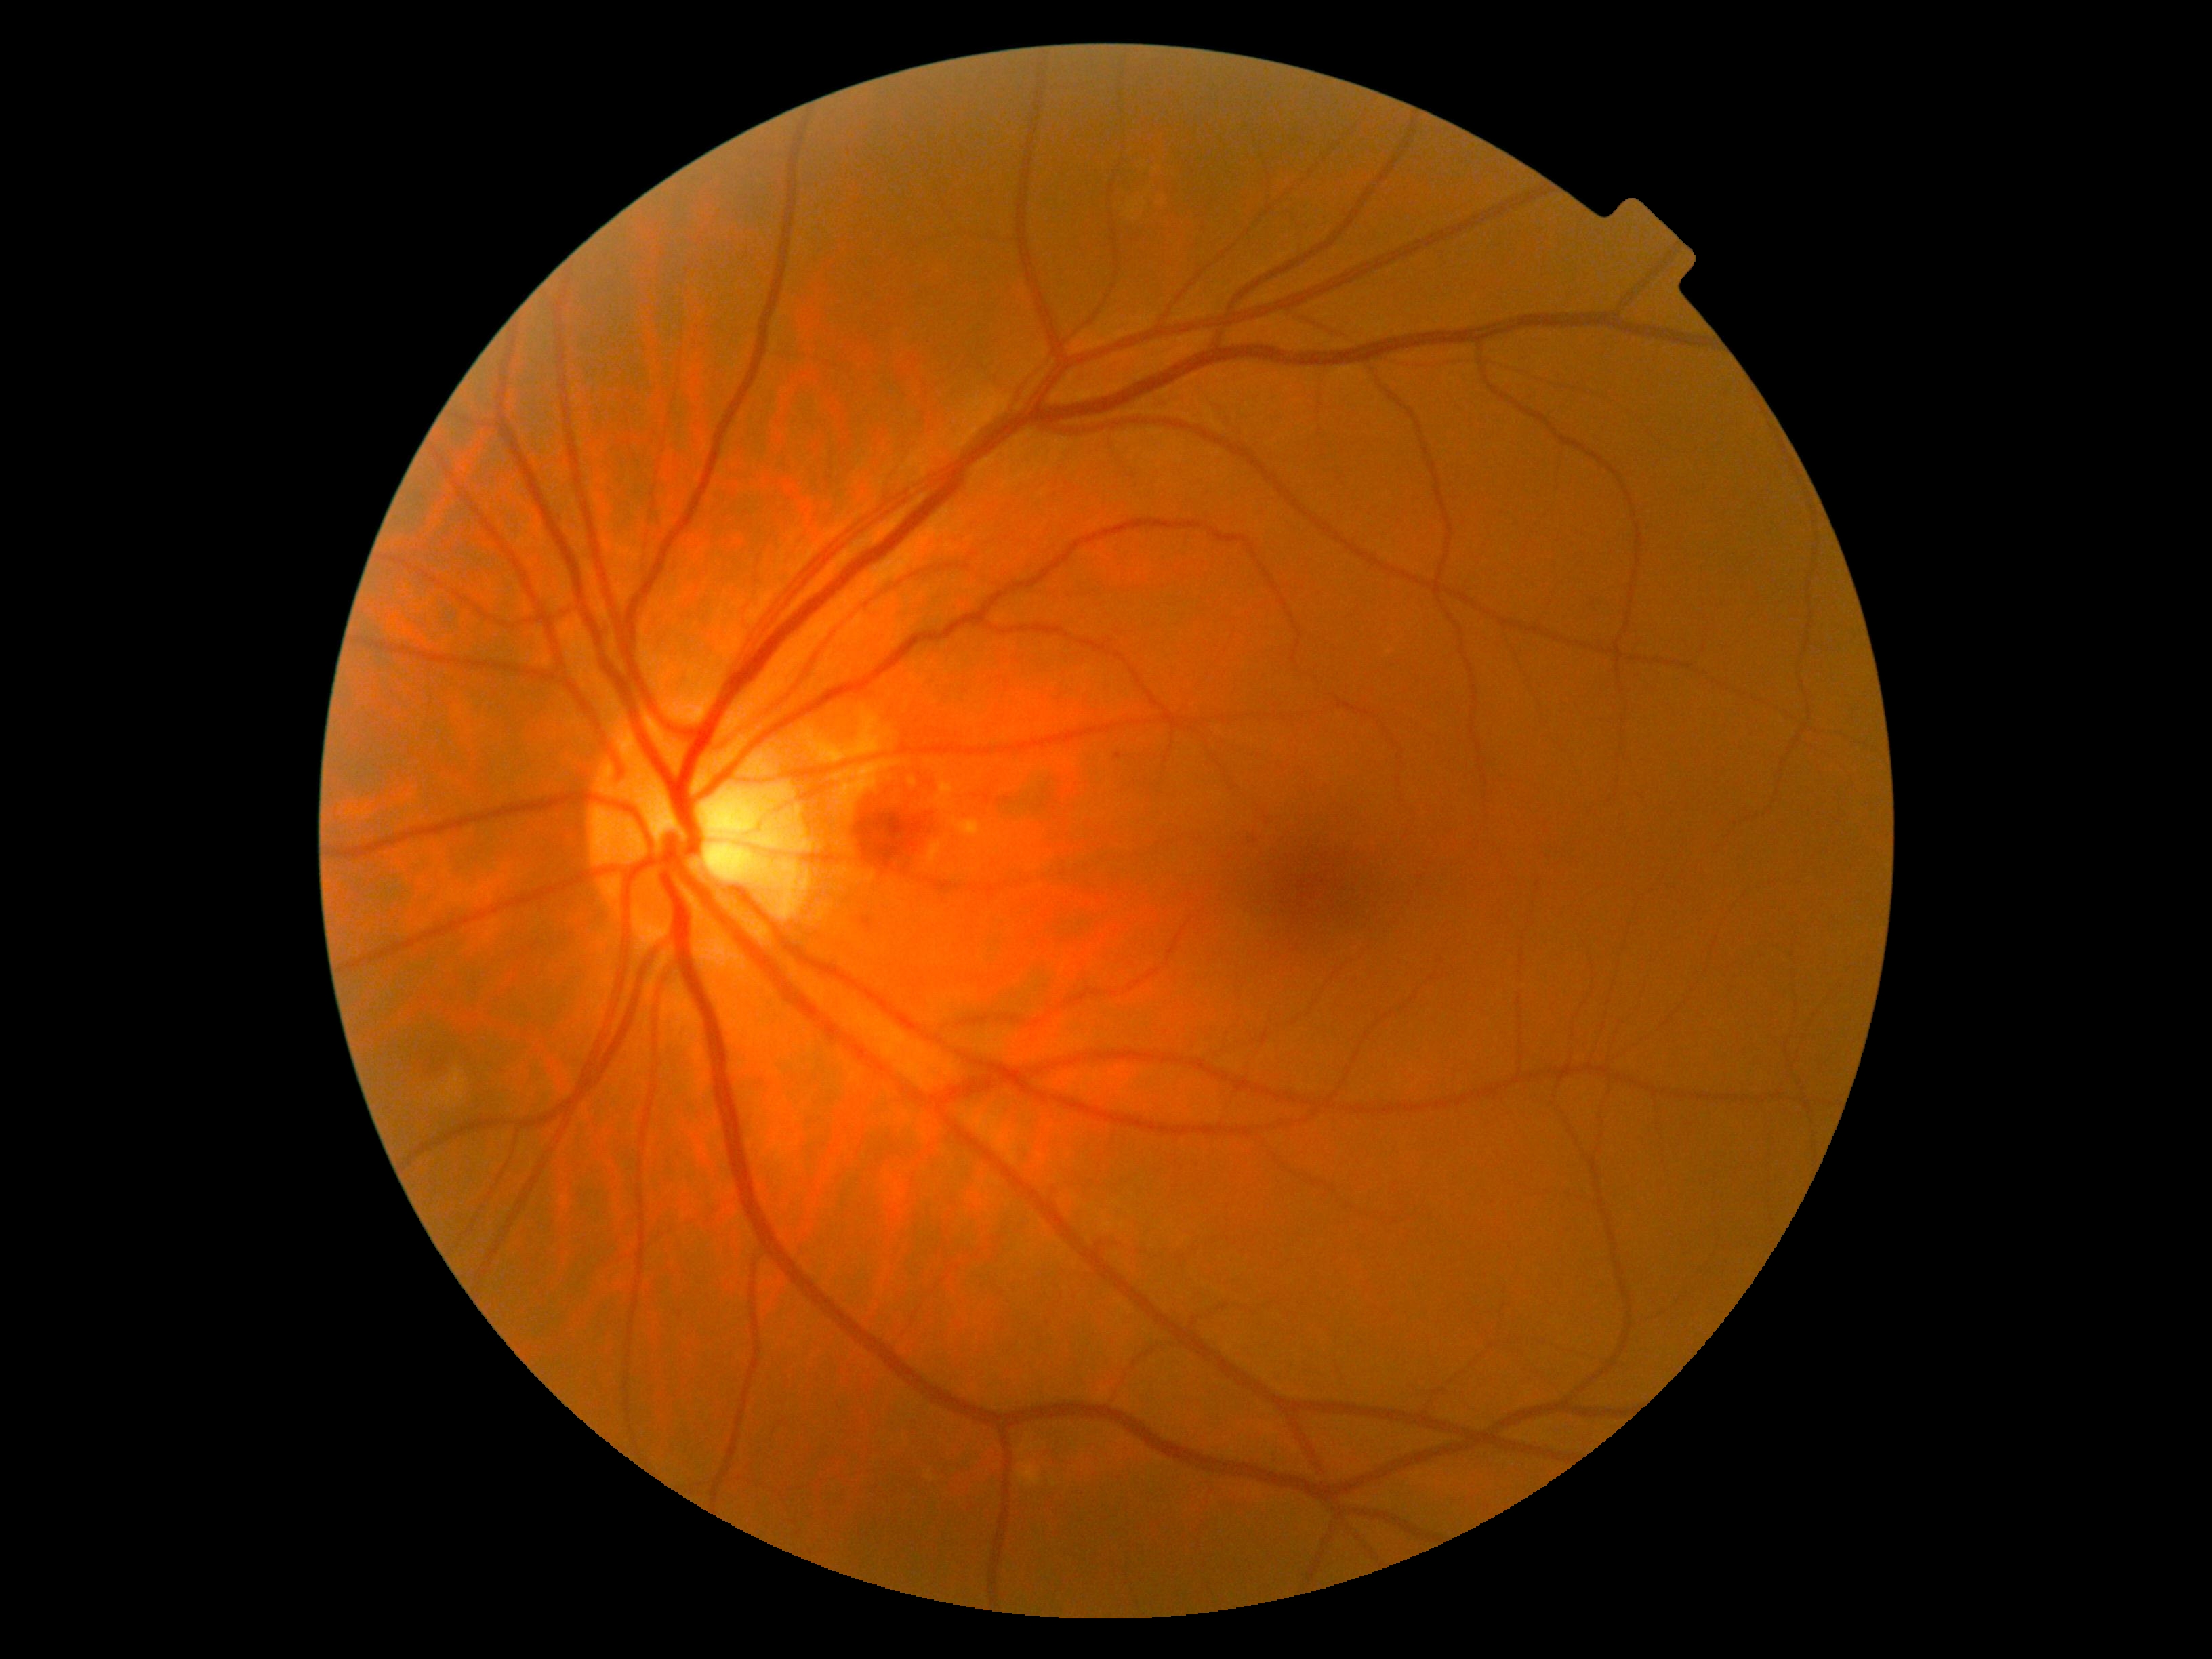
DR class: non-proliferative diabetic retinopathy.
Diabetic retinopathy grade is 2 (moderate NPDR).